Cropped to the optic nerve head; 240x240; fundus photo — 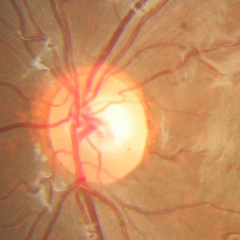
No glaucomatous optic neuropathy.